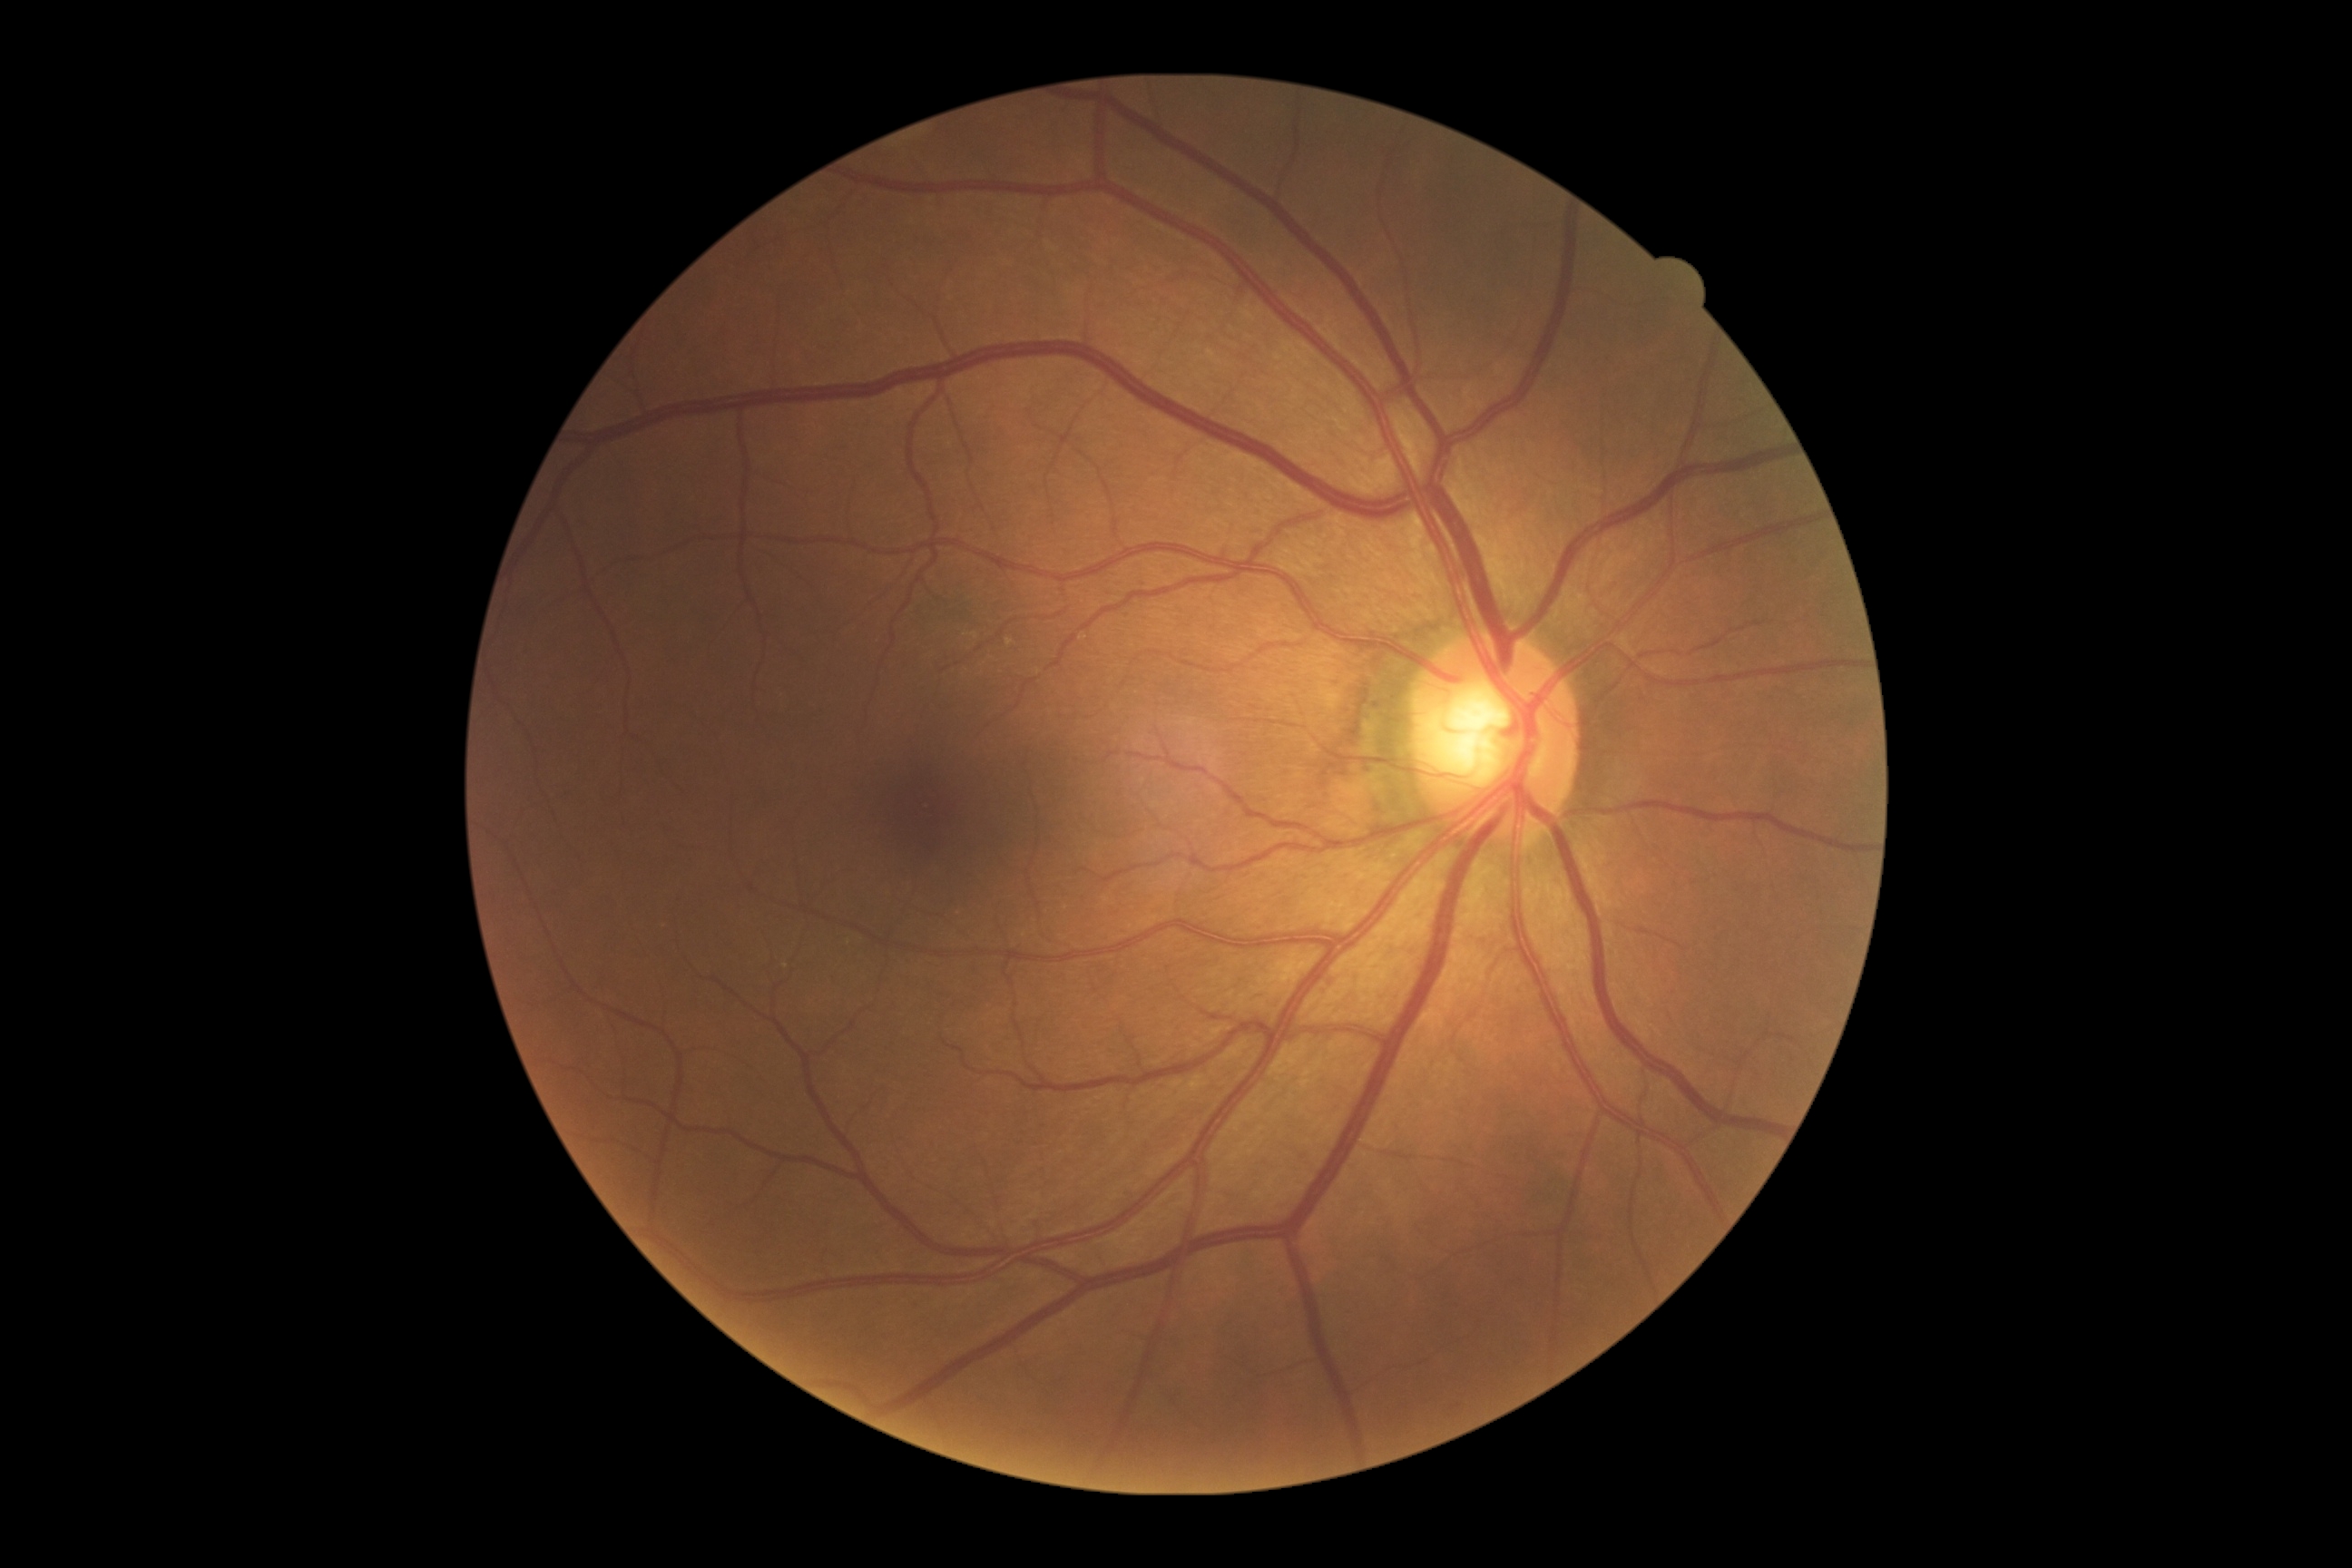

DR severity: 0.